RetCam wide-field infant fundus image · image size 640x480 — 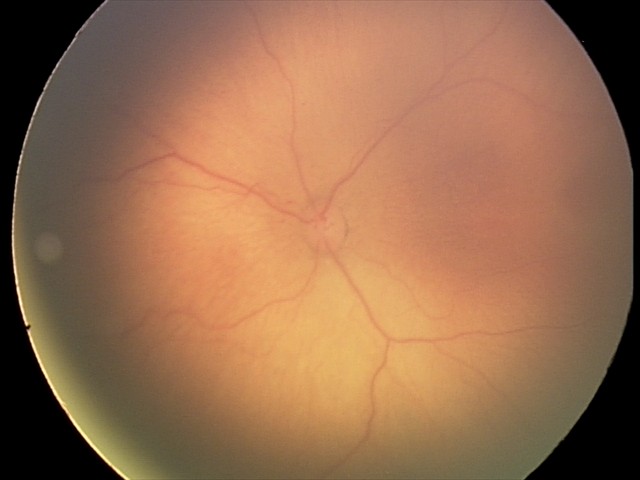
Without plus disease. Diagnosis from this screening exam: retinopathy of prematurity stage 2.